Color fundus image; pupil-dilated:
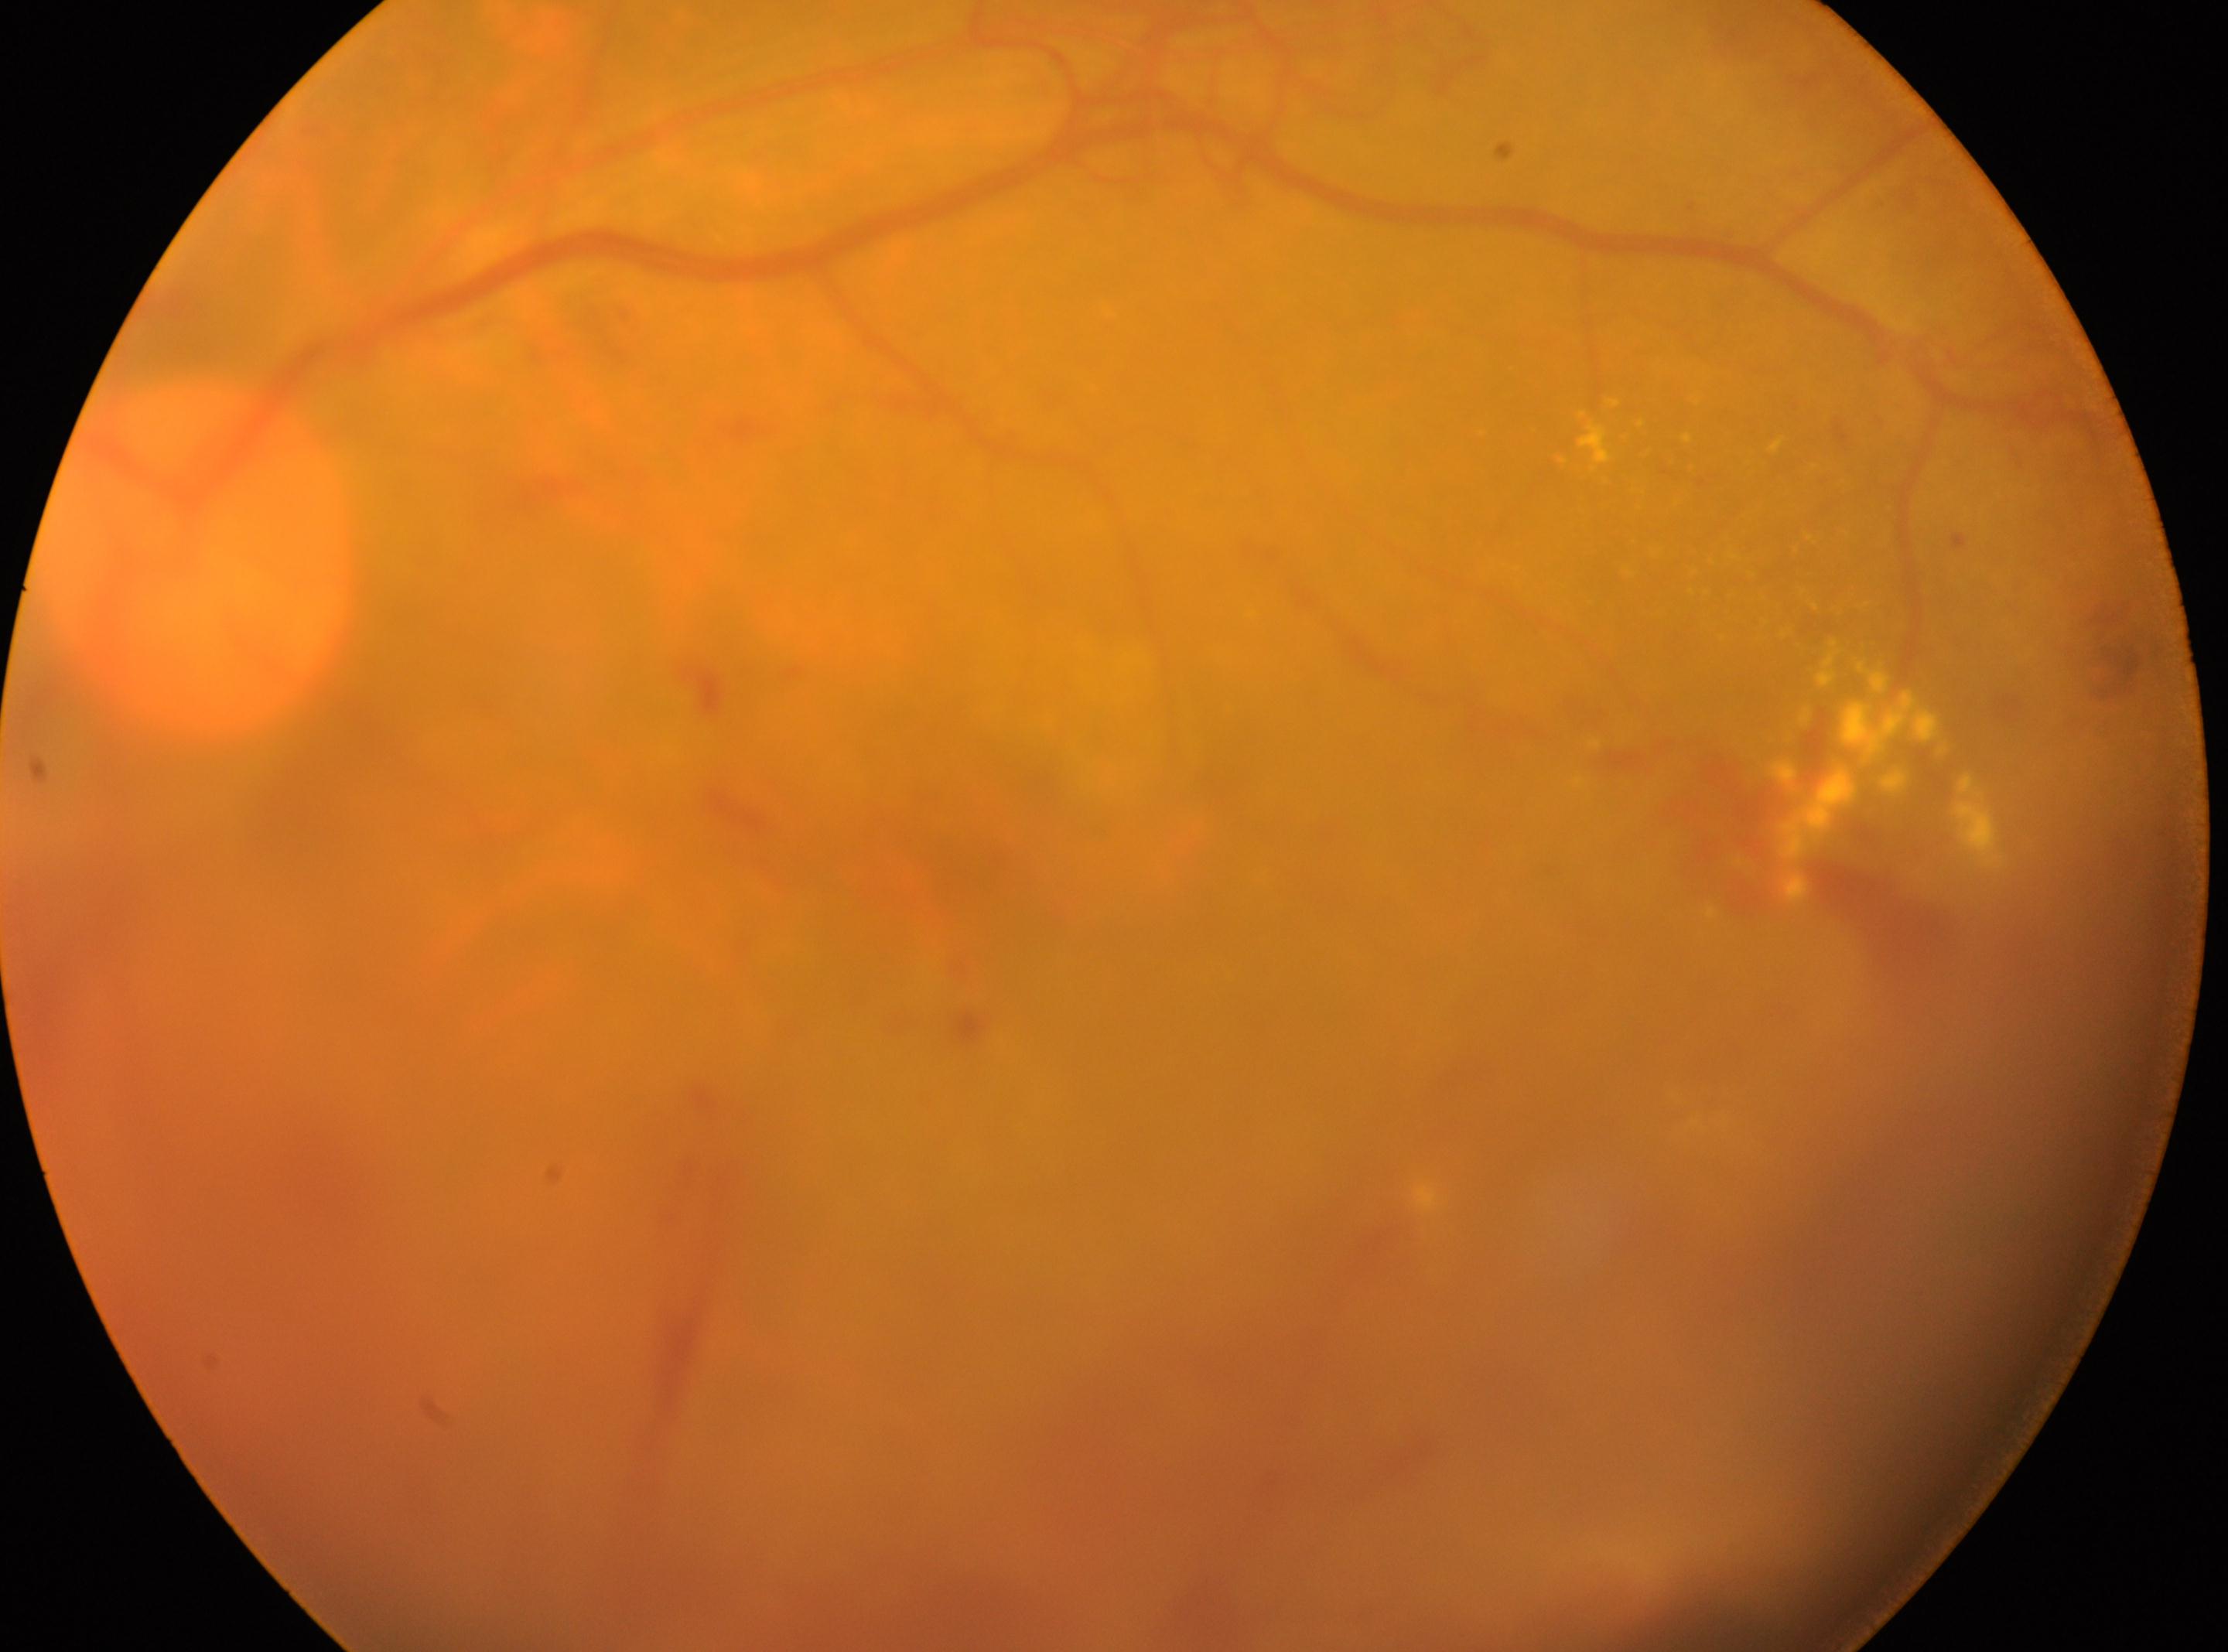
Optic disk: (x: 198, y: 560). Eye: OS. Diabetic retinopathy (DR) is grade 4 — neovascularization and/or vitreous/pre-retinal hemorrhage. Macula center located at (x: 952, y: 834).